45° FOV — 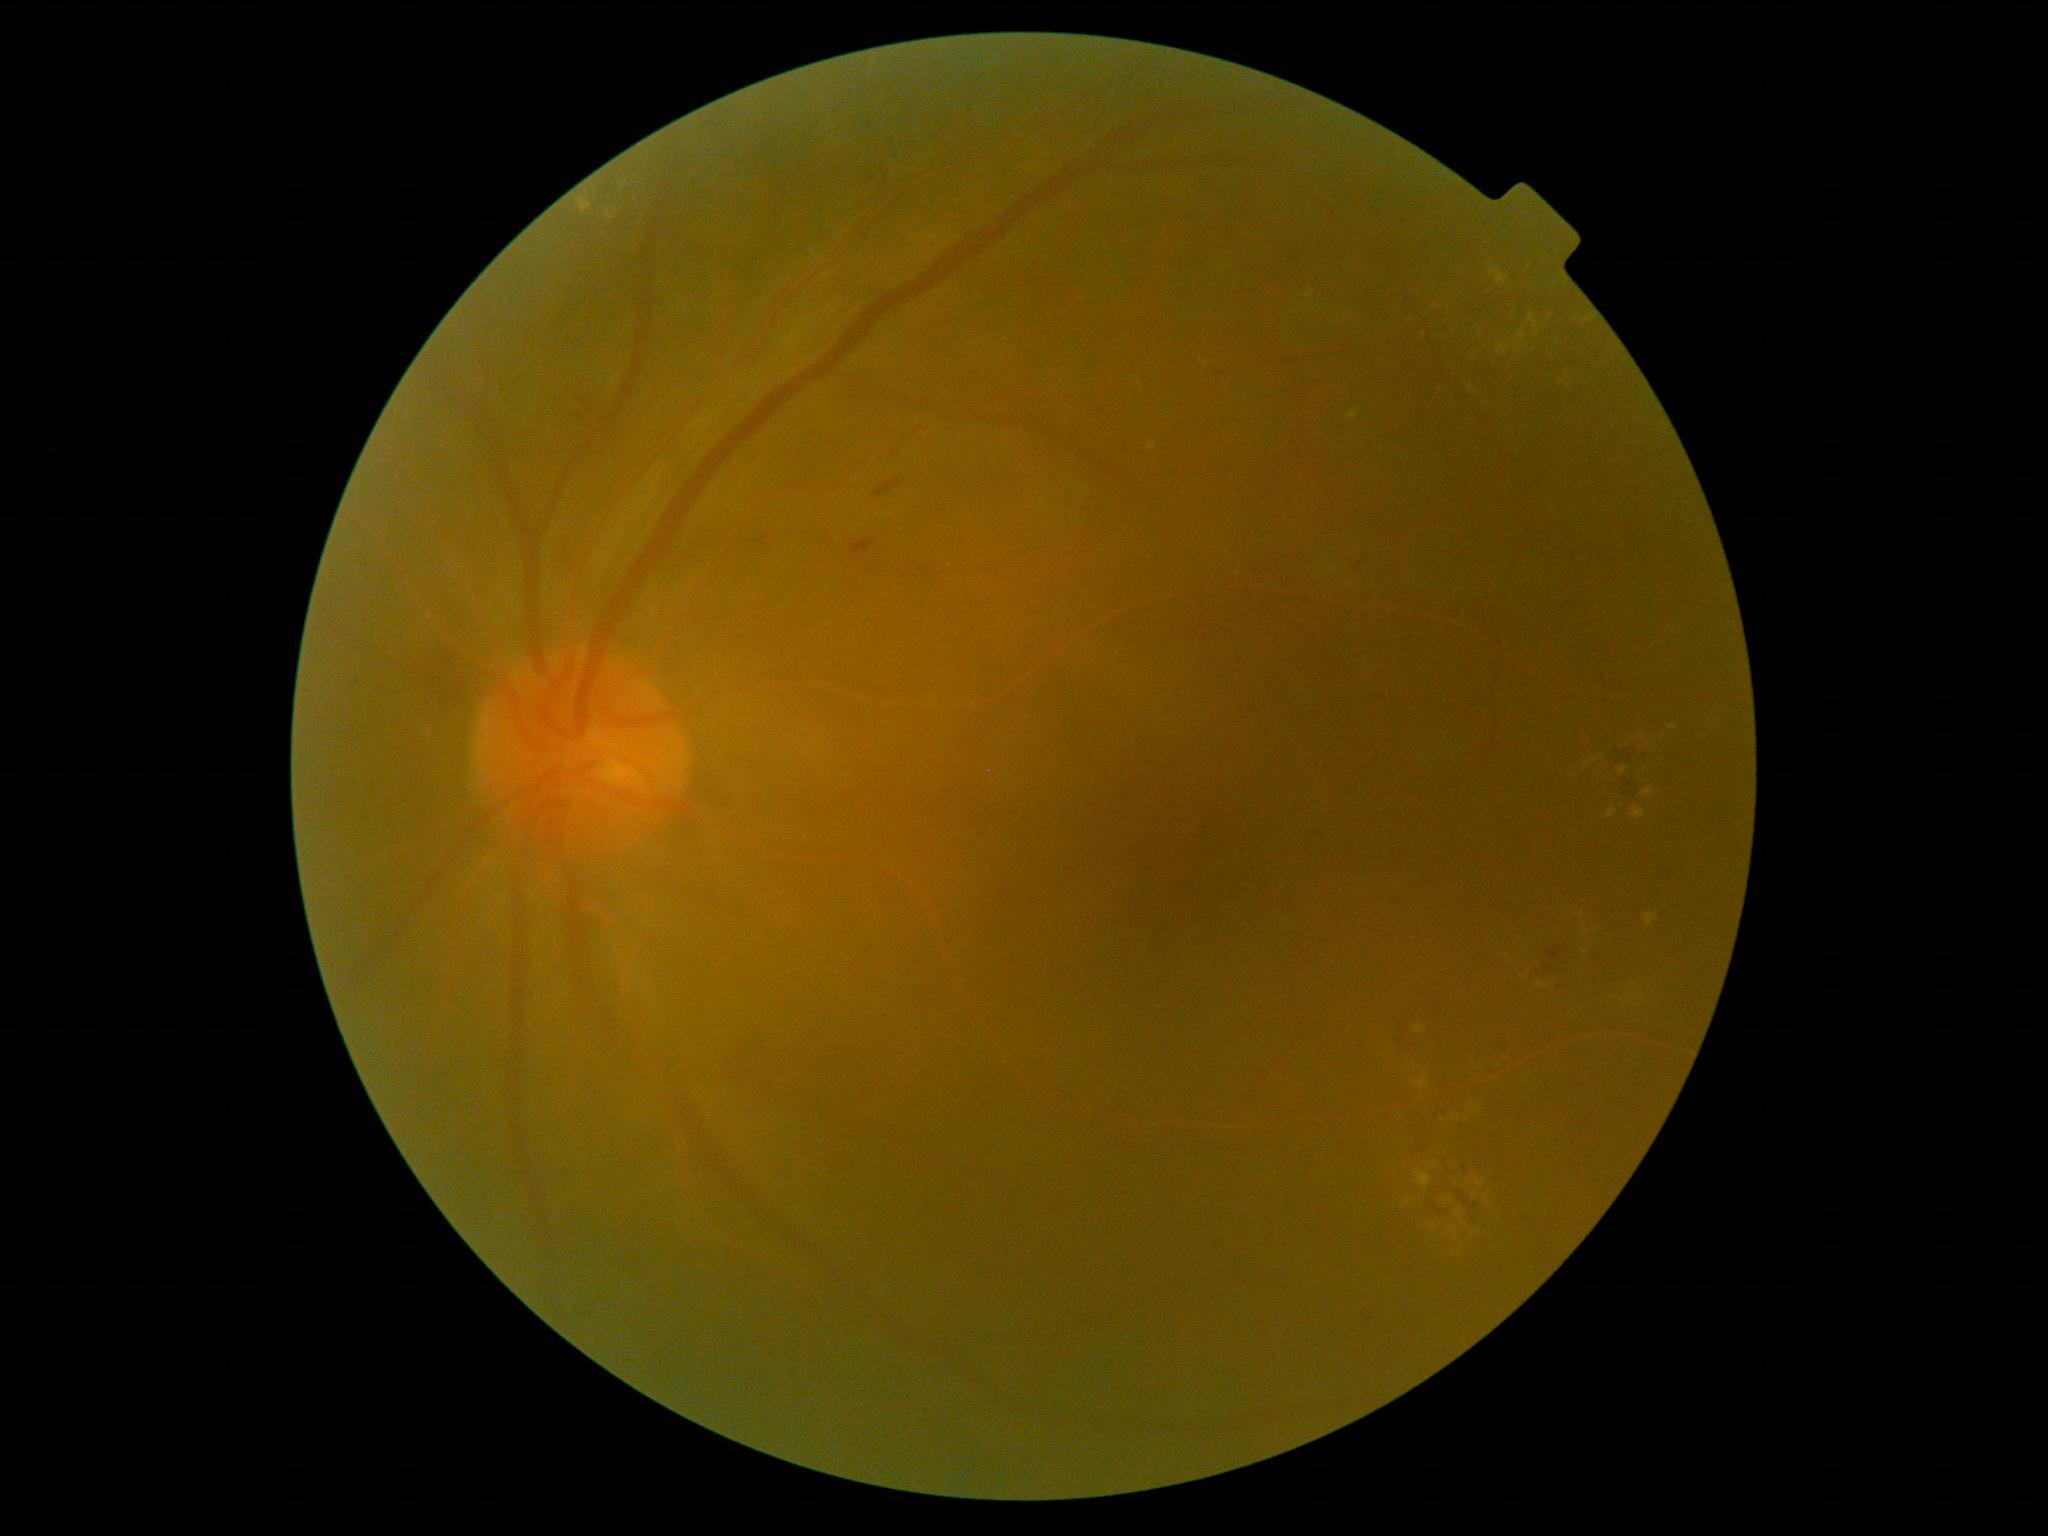
{"partial": true, "dr_grade": 2, "dr_grade_name": "moderate NPDR", "lesions": {"ex": [[1528, 315, 1535, 323], [1437, 1194, 1454, 1206], [1585, 758, 1598, 766], [1582, 945, 1591, 955], [1417, 1170, 1431, 1190], [1497, 343, 1510, 356], [1629, 735, 1644, 746], [1643, 789, 1654, 799], [1149, 443, 1157, 452], [1416, 1078, 1427, 1088], [1519, 330, 1528, 343]], "ex_small": [[1533, 327], [1520, 350], [1508, 956]]}}